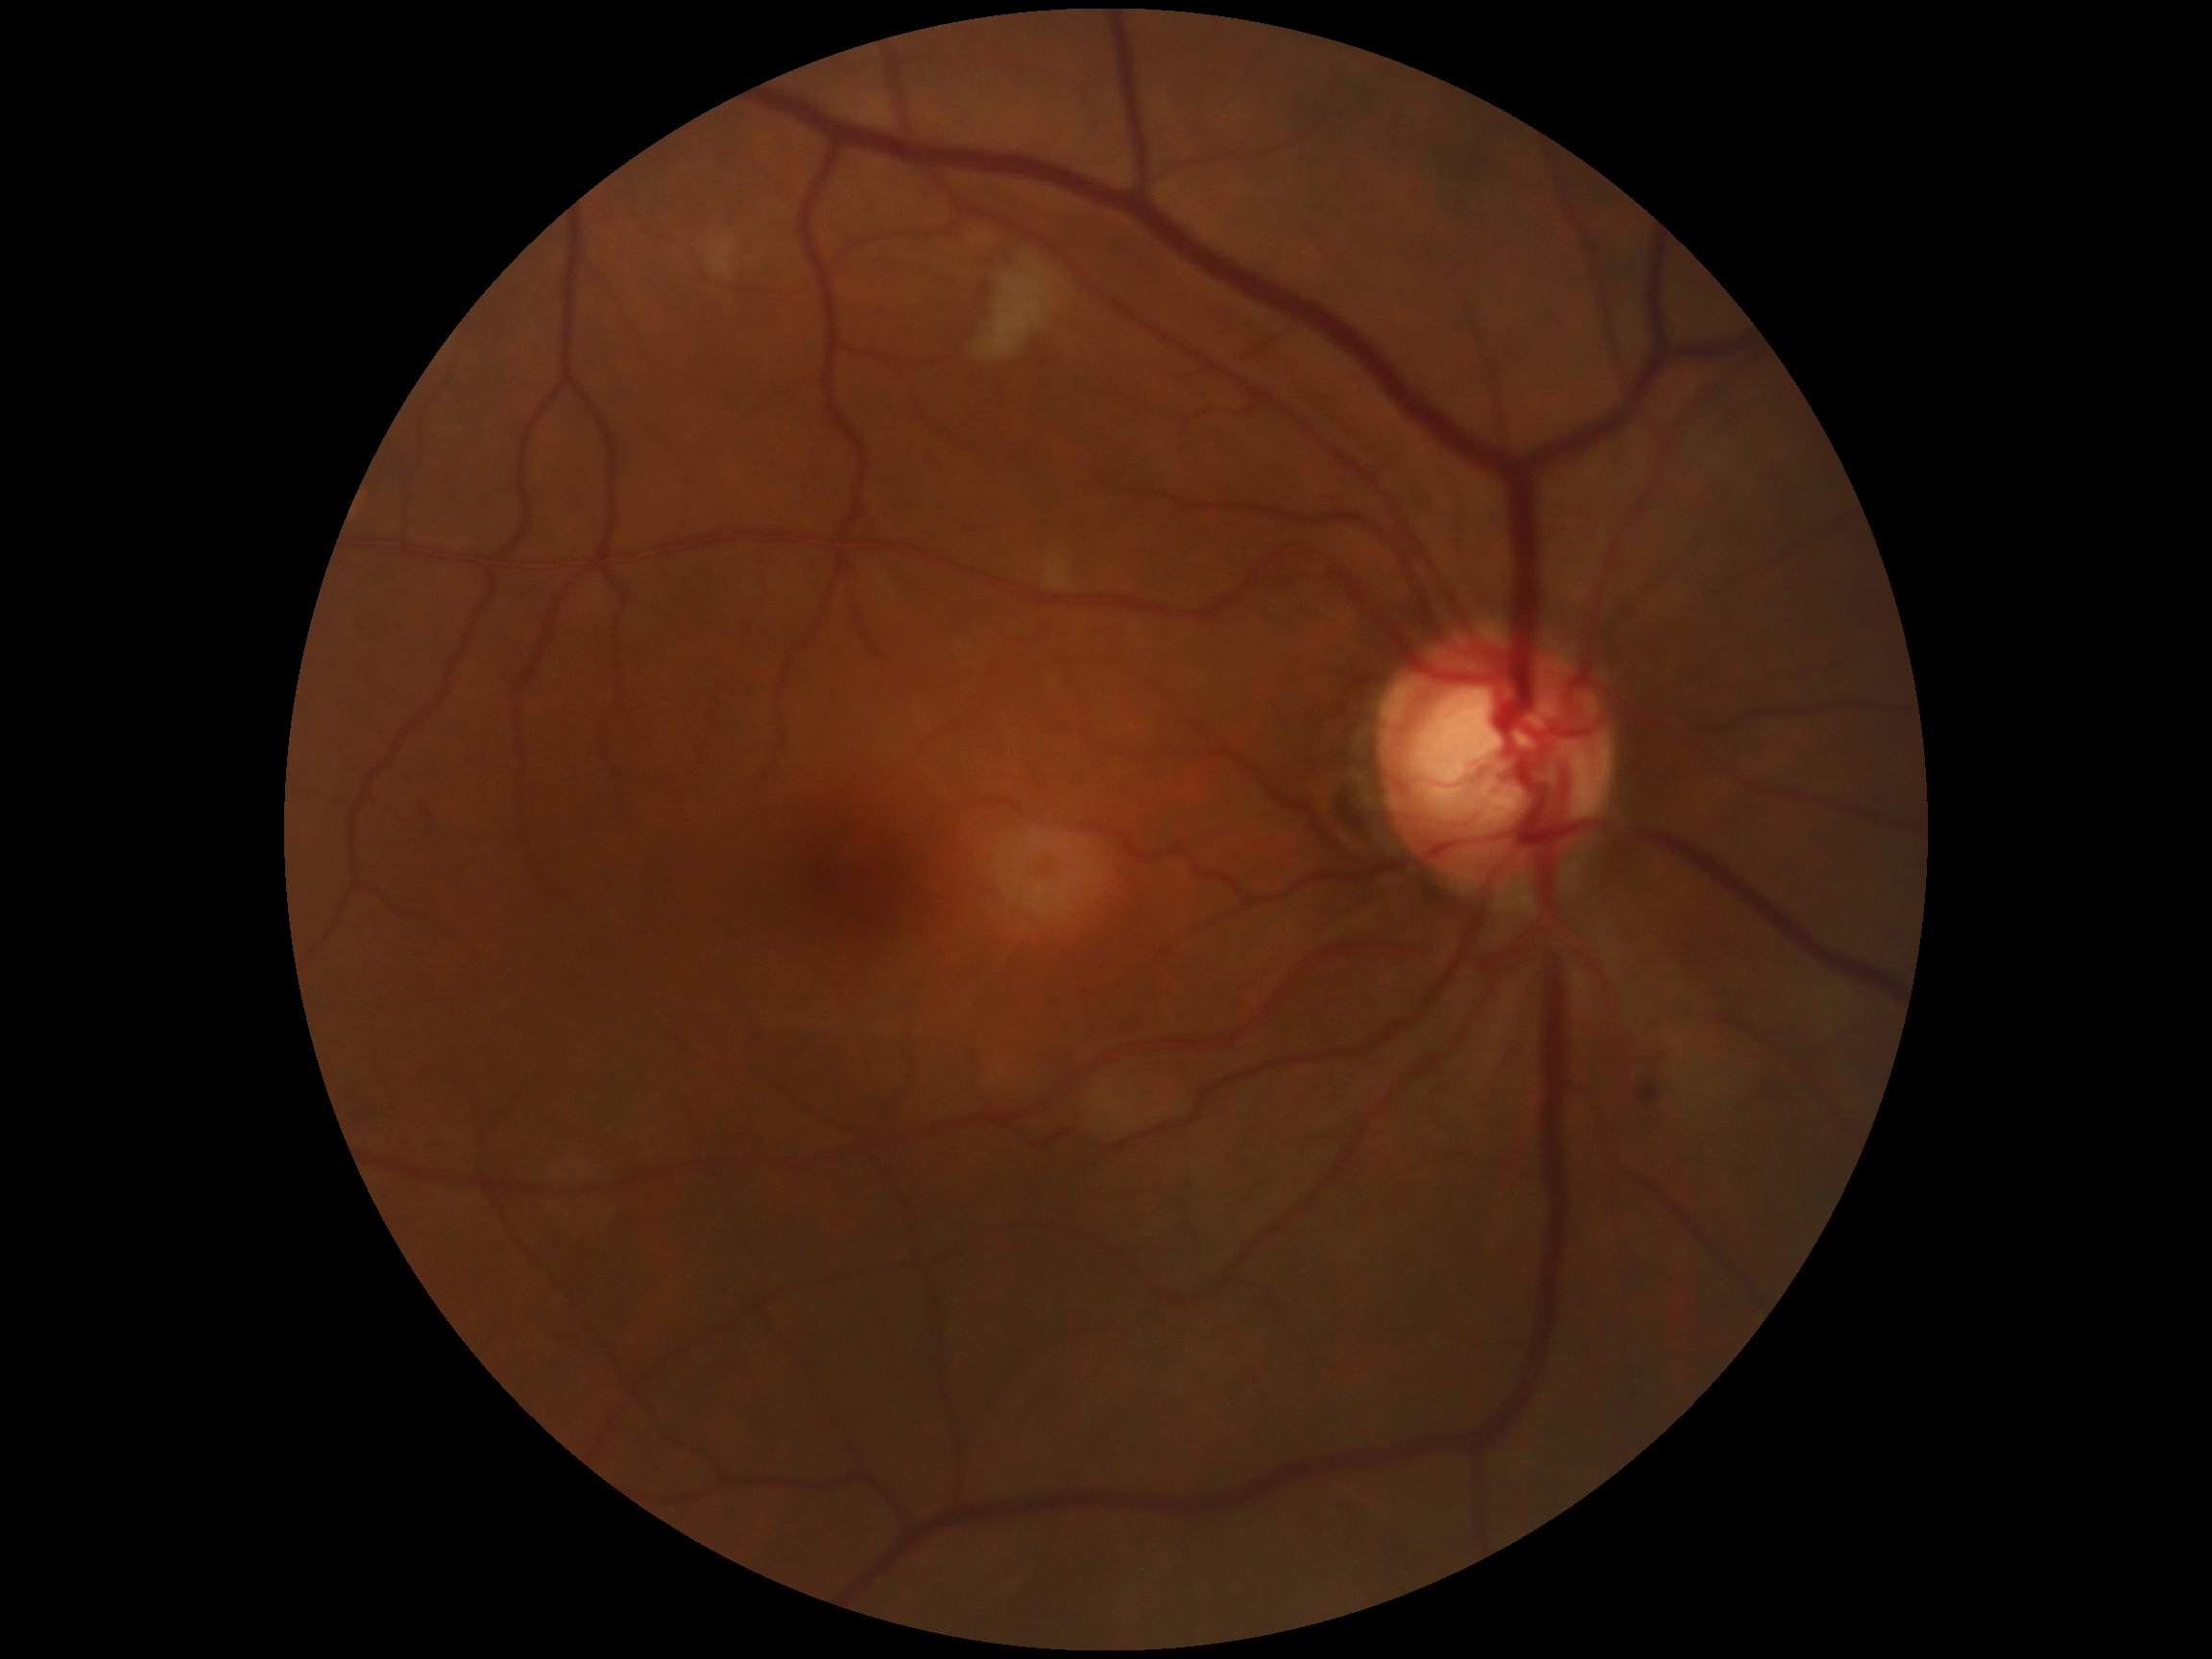 diabetic retinopathy=2, DR class=non-proliferative diabetic retinopathy.